Pediatric wide-field fundus photograph
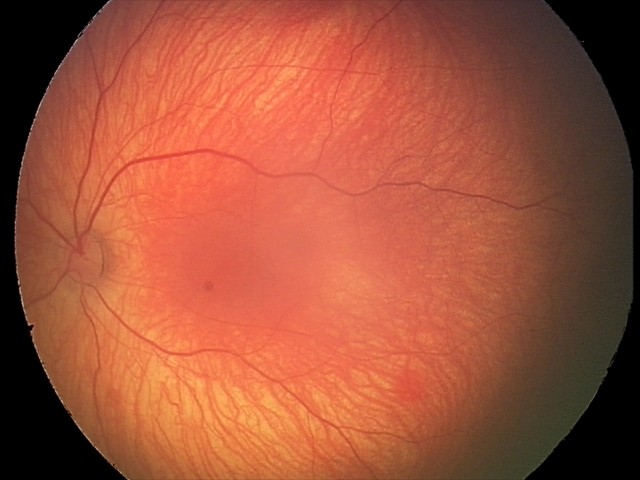
From an examination with diagnosis of retinal hemorrhages.